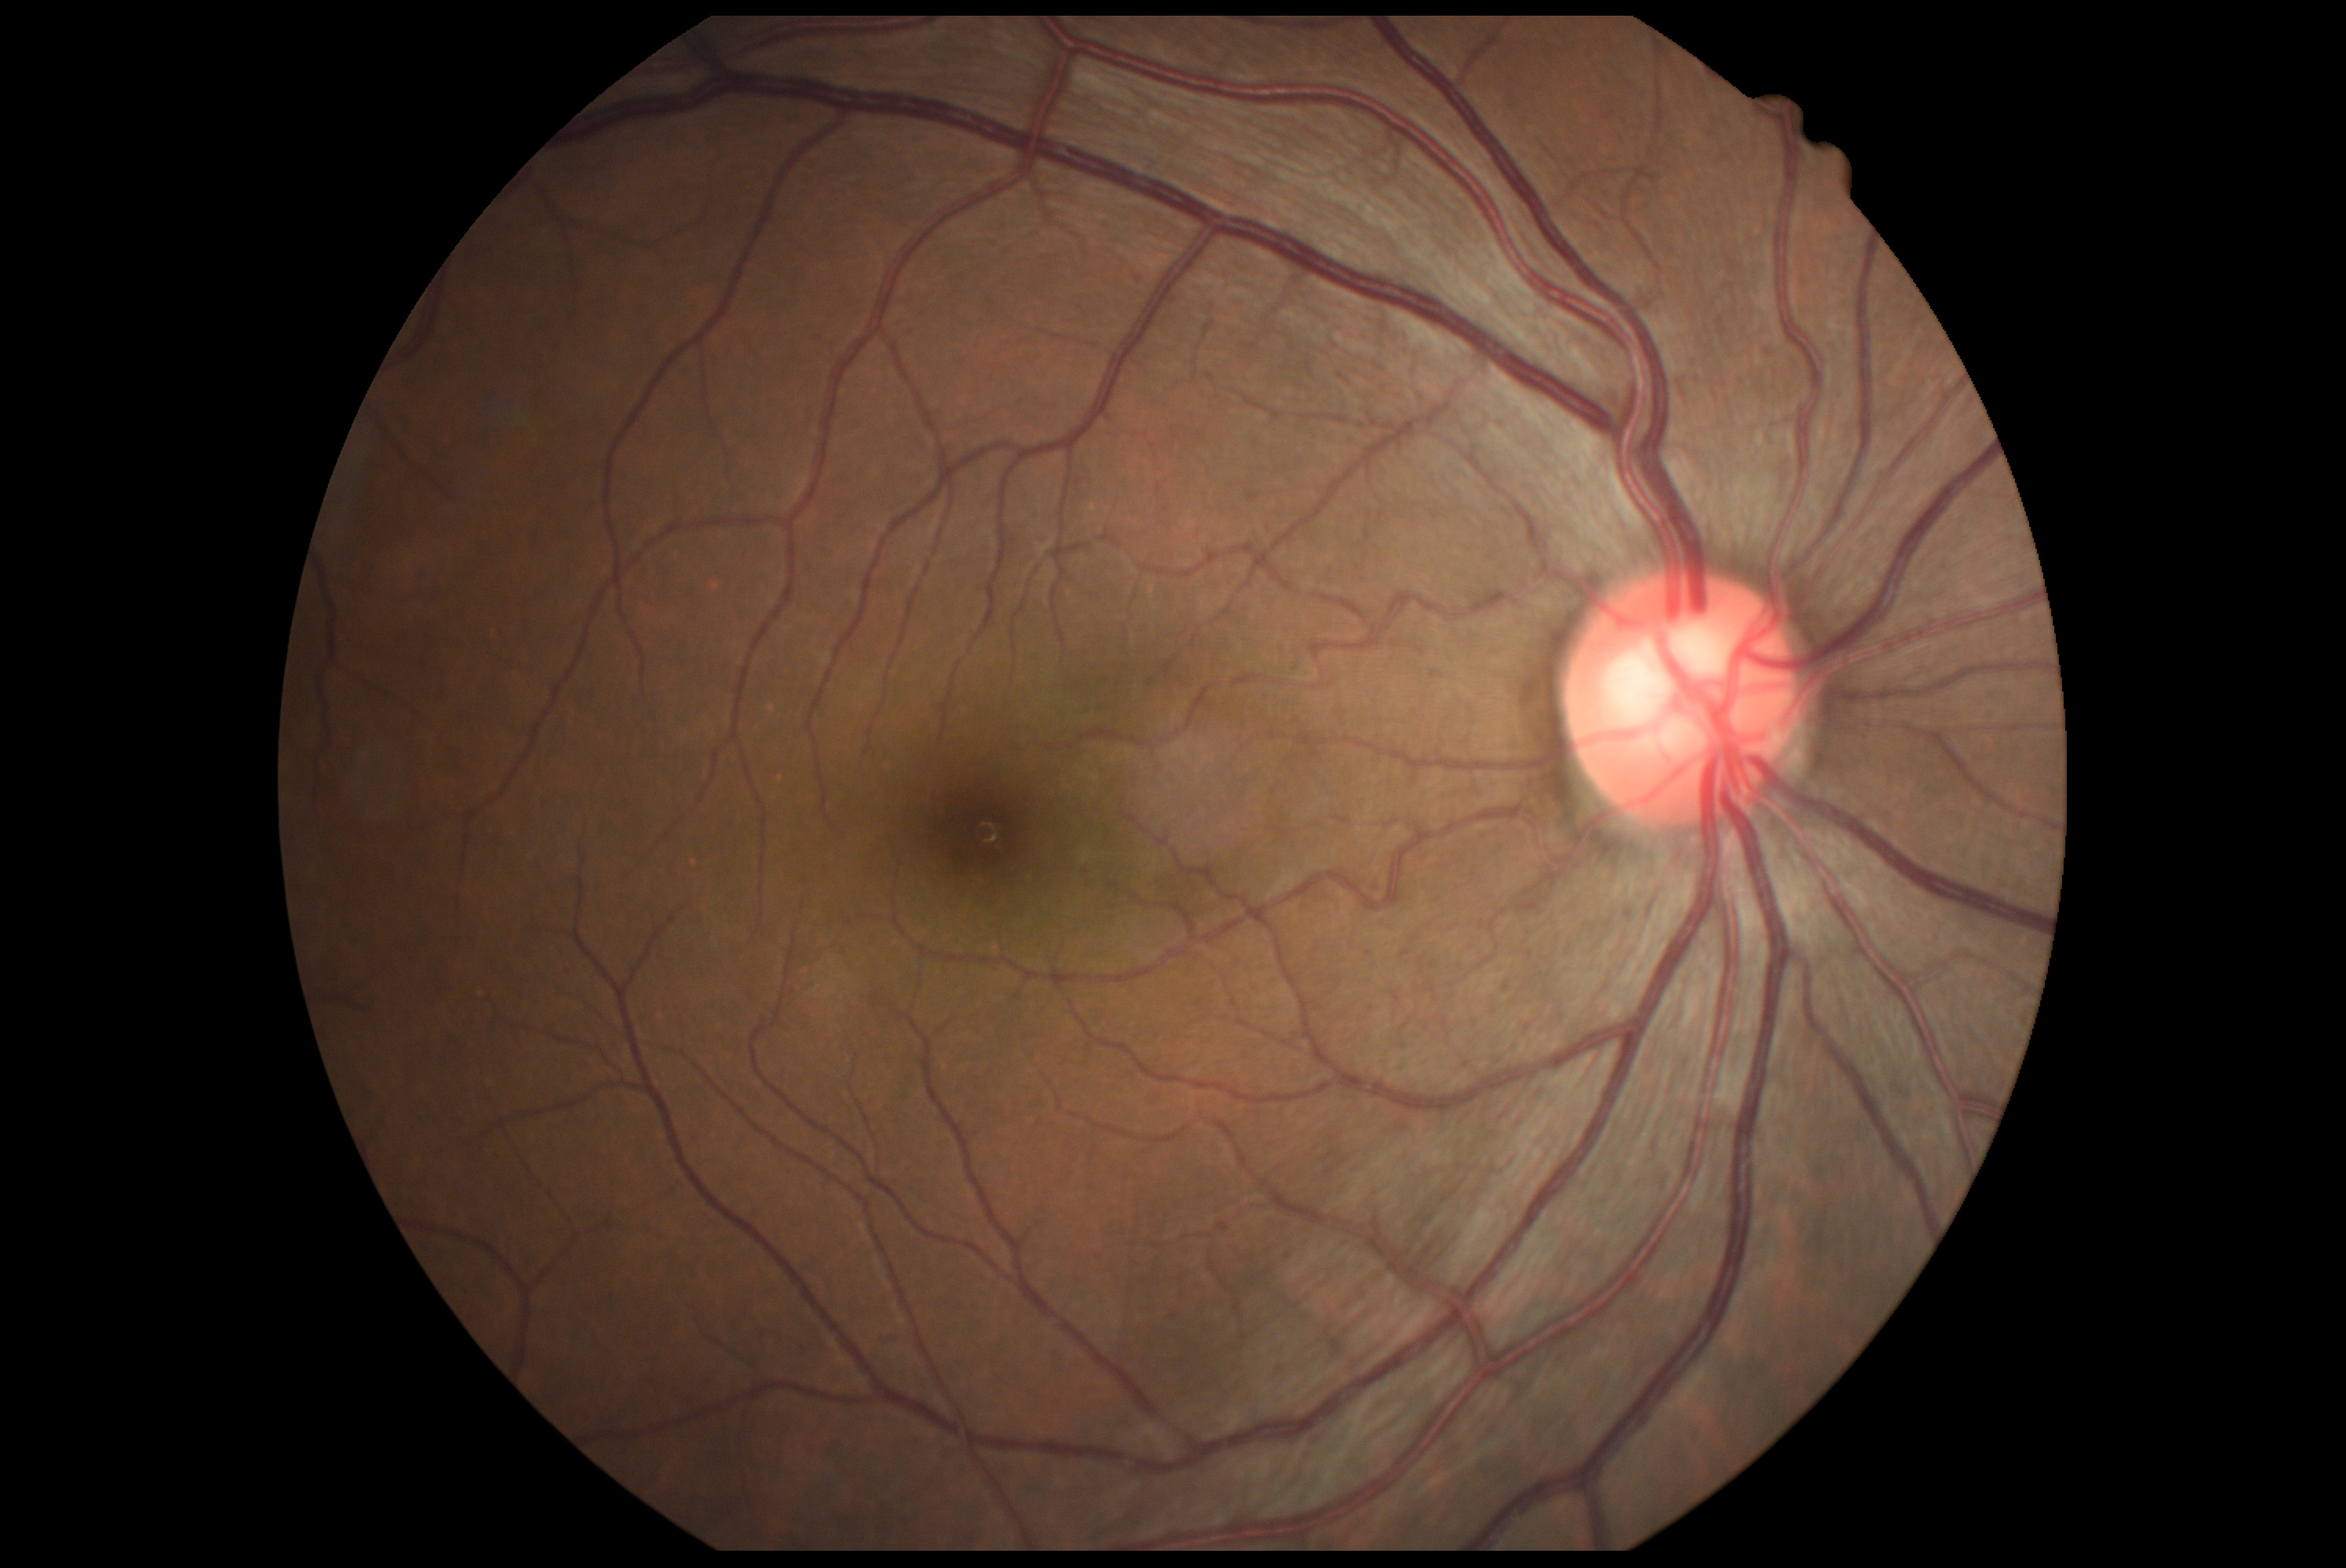

DR severity is grade 0 (no apparent retinopathy).